2212x1659px
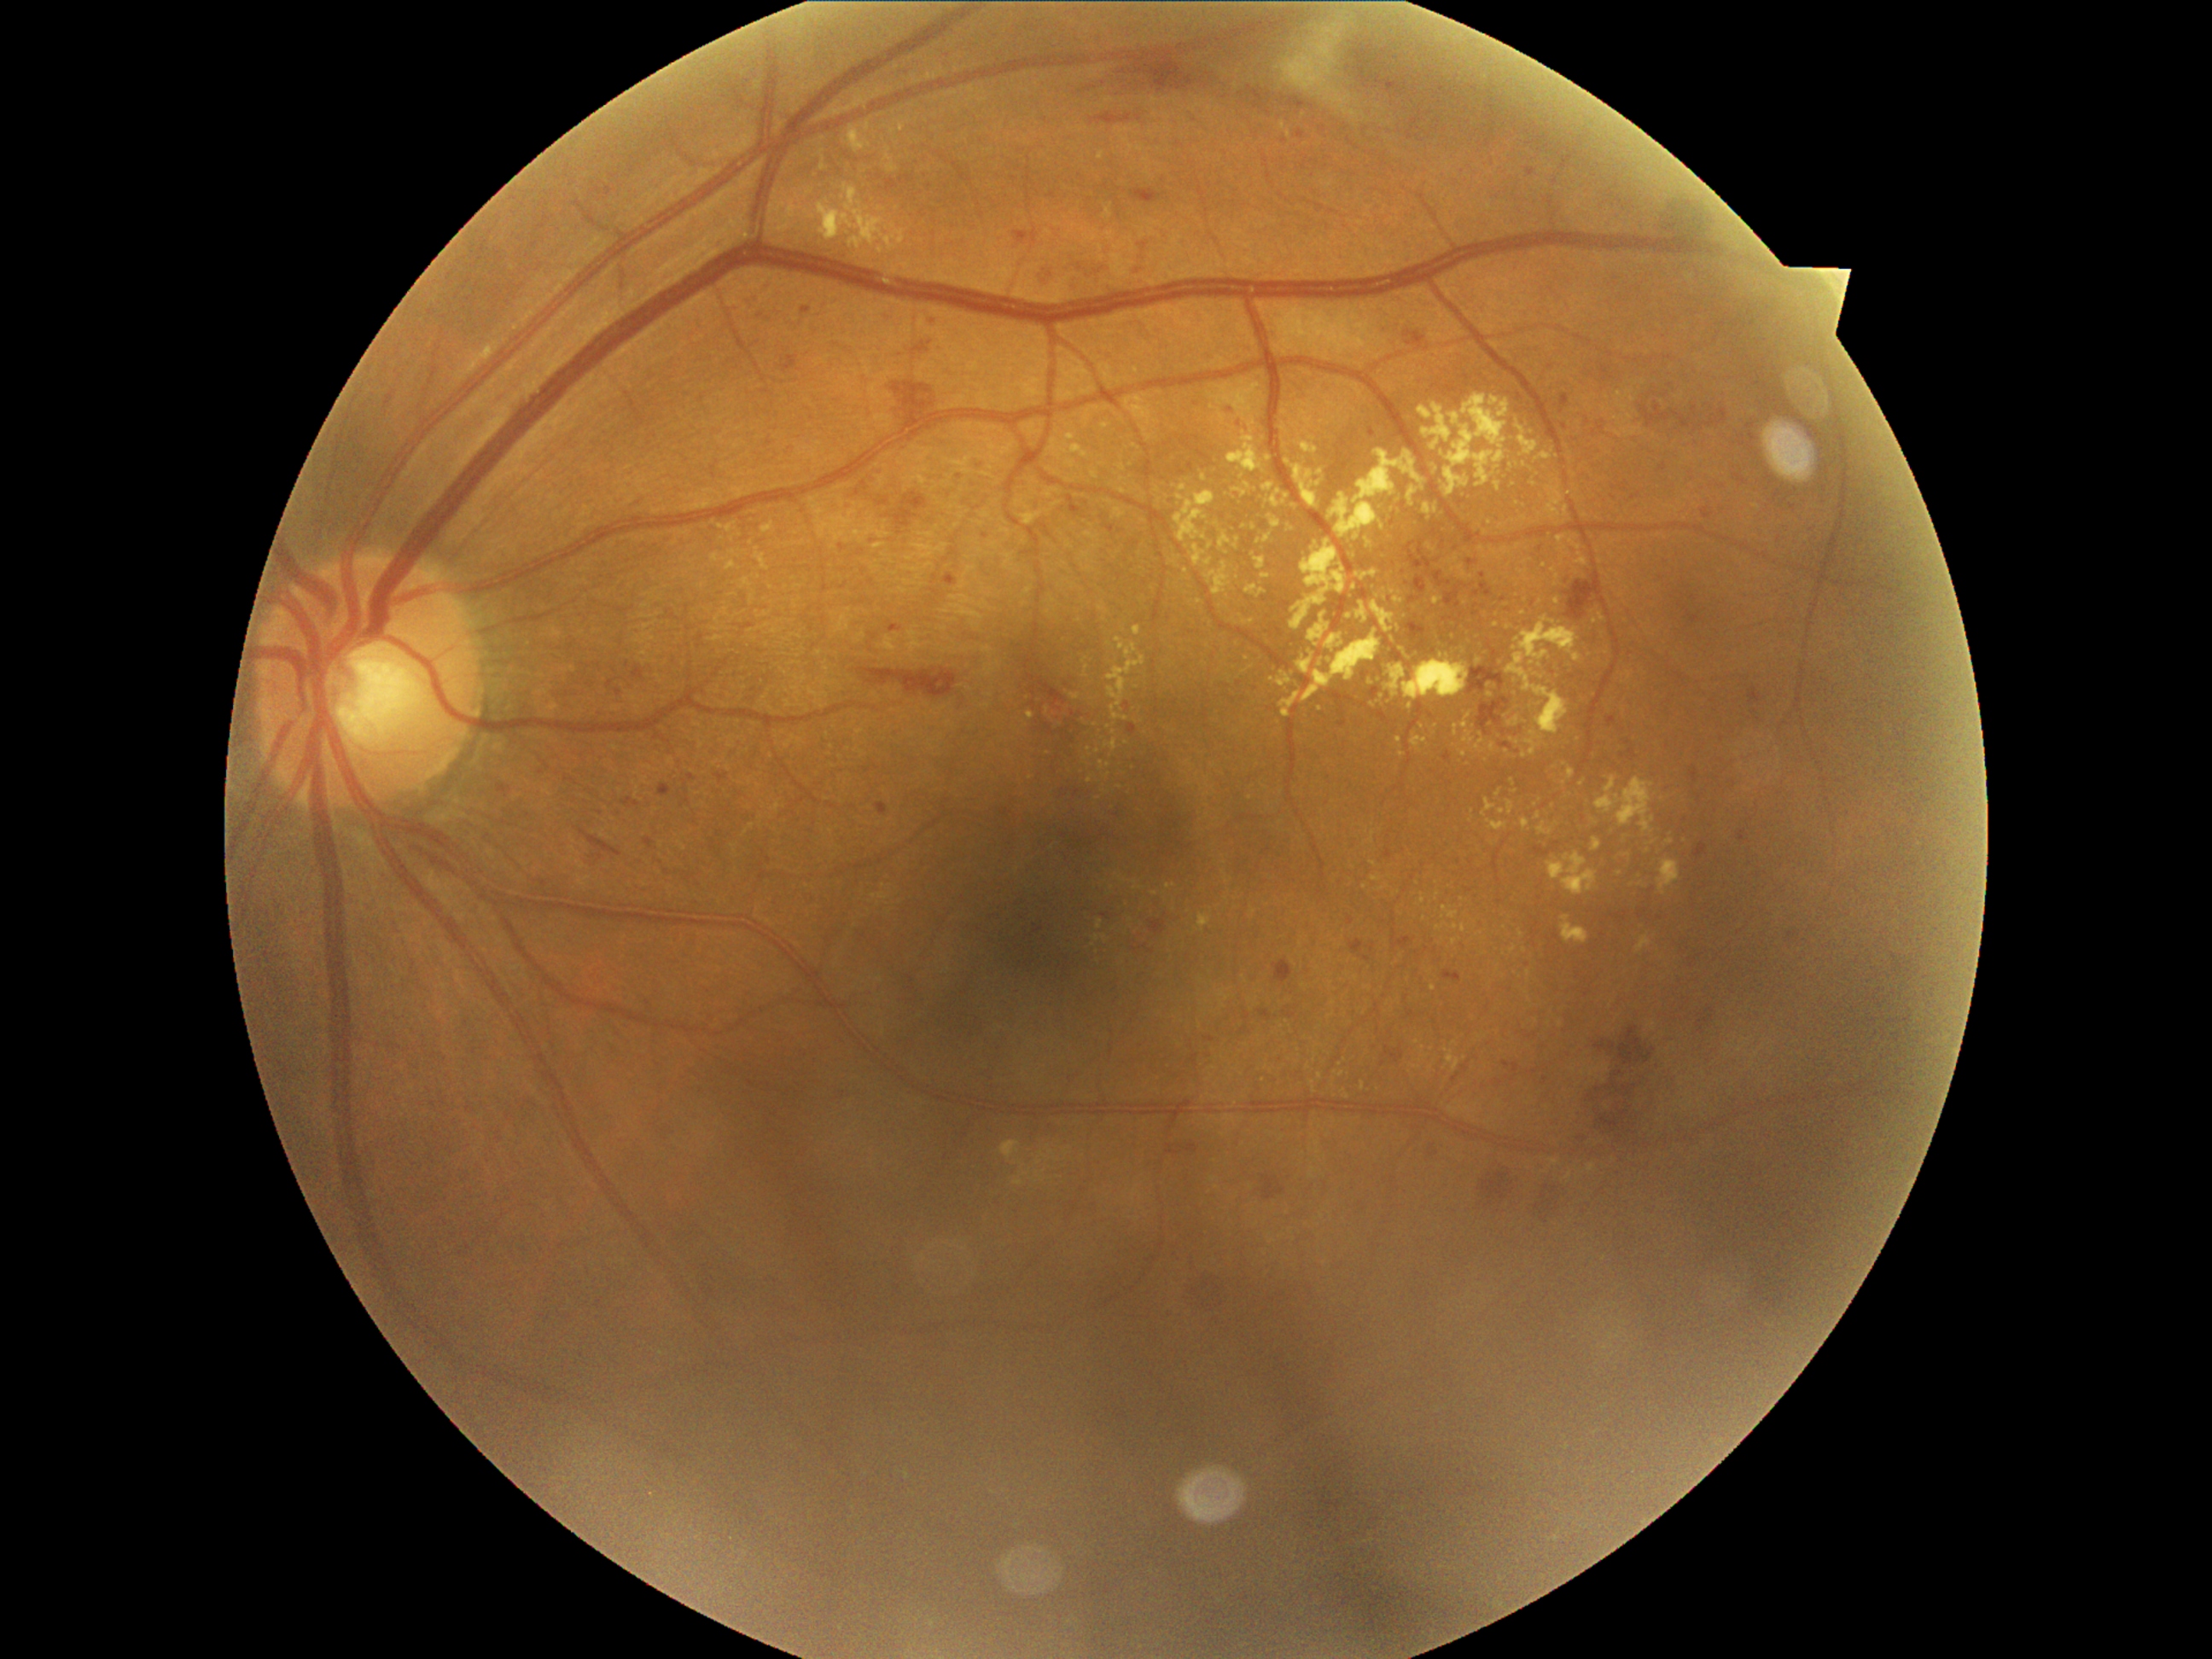

partial: true
dr_grade: 2
dr_grade_name: moderate NPDR
lesions:
  ex:
    - x1=1510 y1=465 x2=1520 y2=472
    - x1=1233 y1=537 x2=1240 y2=549
    - x1=1441 y1=655 x2=1450 y2=658
    - x1=1569 y1=540 x2=1581 y2=552
    - x1=1561 y1=853 x2=1598 y2=895
    - x1=1214 y1=521 x2=1231 y2=550
    - x1=1443 y1=907 x2=1458 y2=921
    - x1=1626 y1=672 x2=1633 y2=680
    - x1=1576 y1=557 x2=1588 y2=566
    - x1=1197 y1=914 x2=1213 y2=931
  ex_small_approx:
    - [1158, 490]
    - [1553, 807]
    - [1465, 604]
    - [1737, 755]
    - [1374, 863]
    - [1584, 516]
    - [1603, 618]
    - [1402, 756]
    - [1242, 477]